2361x1568px.
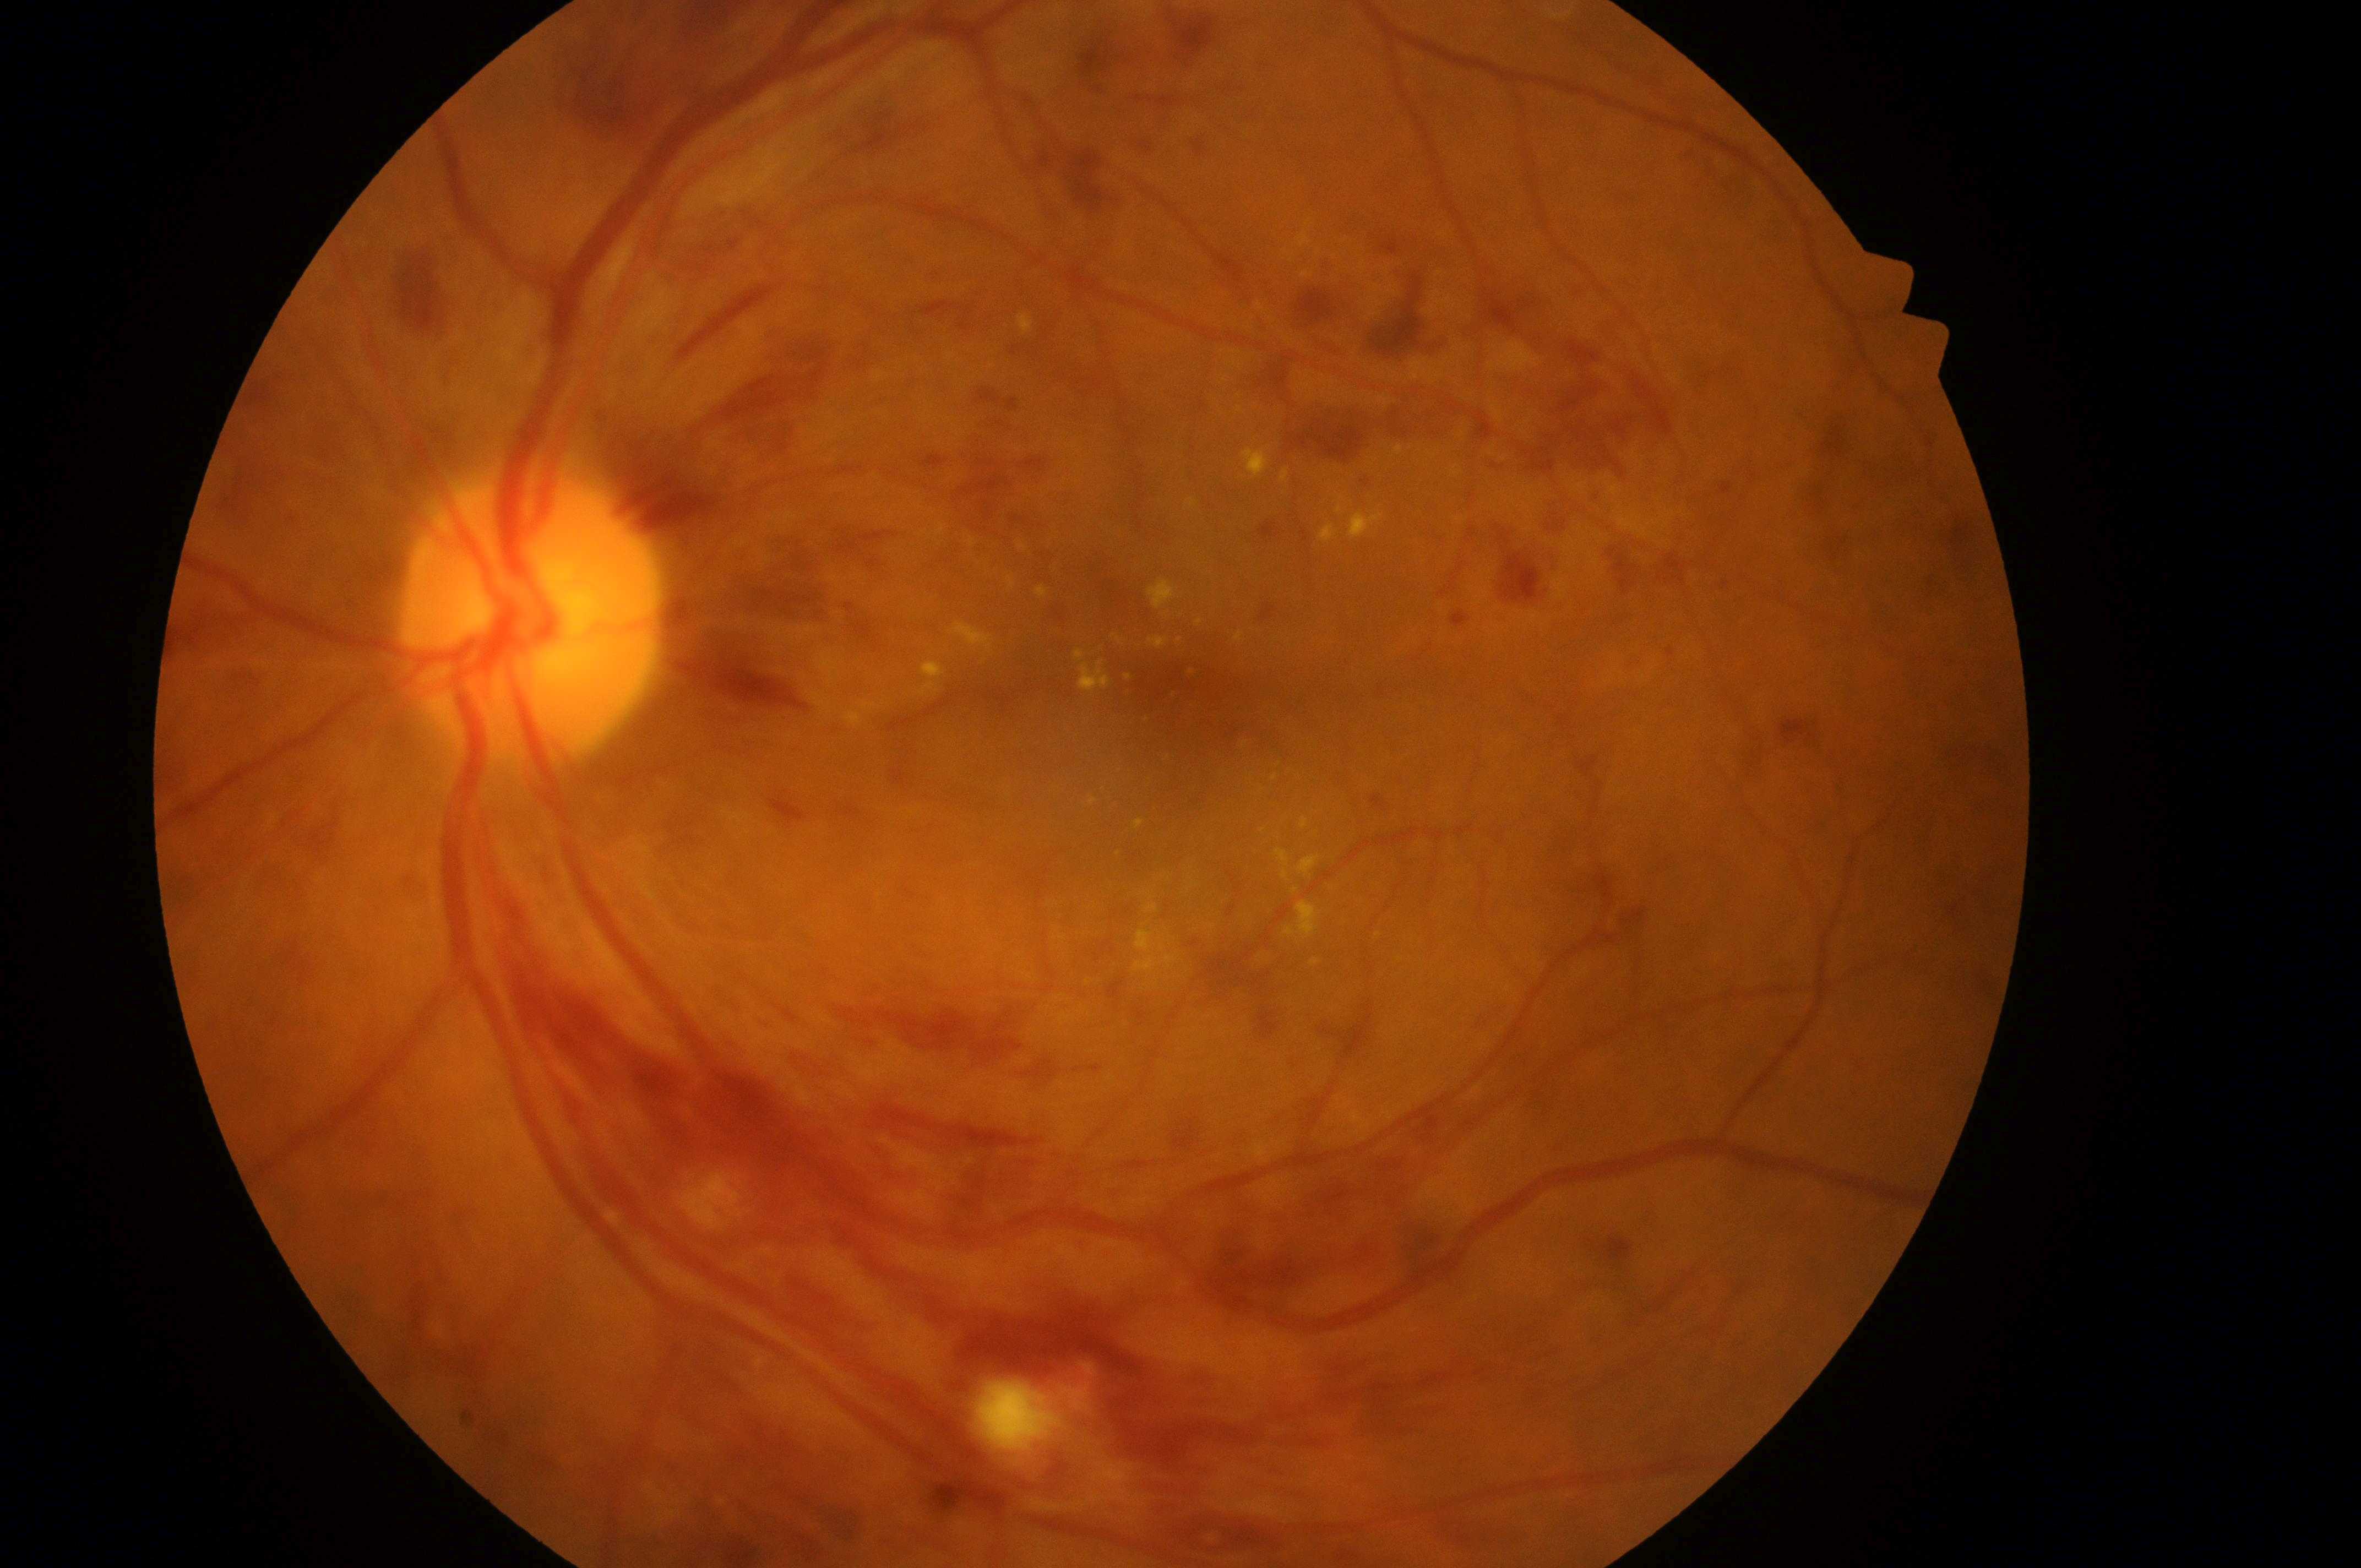
OS
retinopathy=grade 3 — more than 20 intraretinal hemorrhages in each of 4 quadrants, definite venous beading in 2 or more quadrants, or prominent intraretinal microvascular abnormalities in 1 or more quadrants, with no signs of proliferative retinopathy
fovea centralis=1188, 699
macular edema=2 — hard exudates within one disc diameter of the macula center
the optic disc=521, 627